FOV: 45 degrees; fundus photo; image size 2048x1536
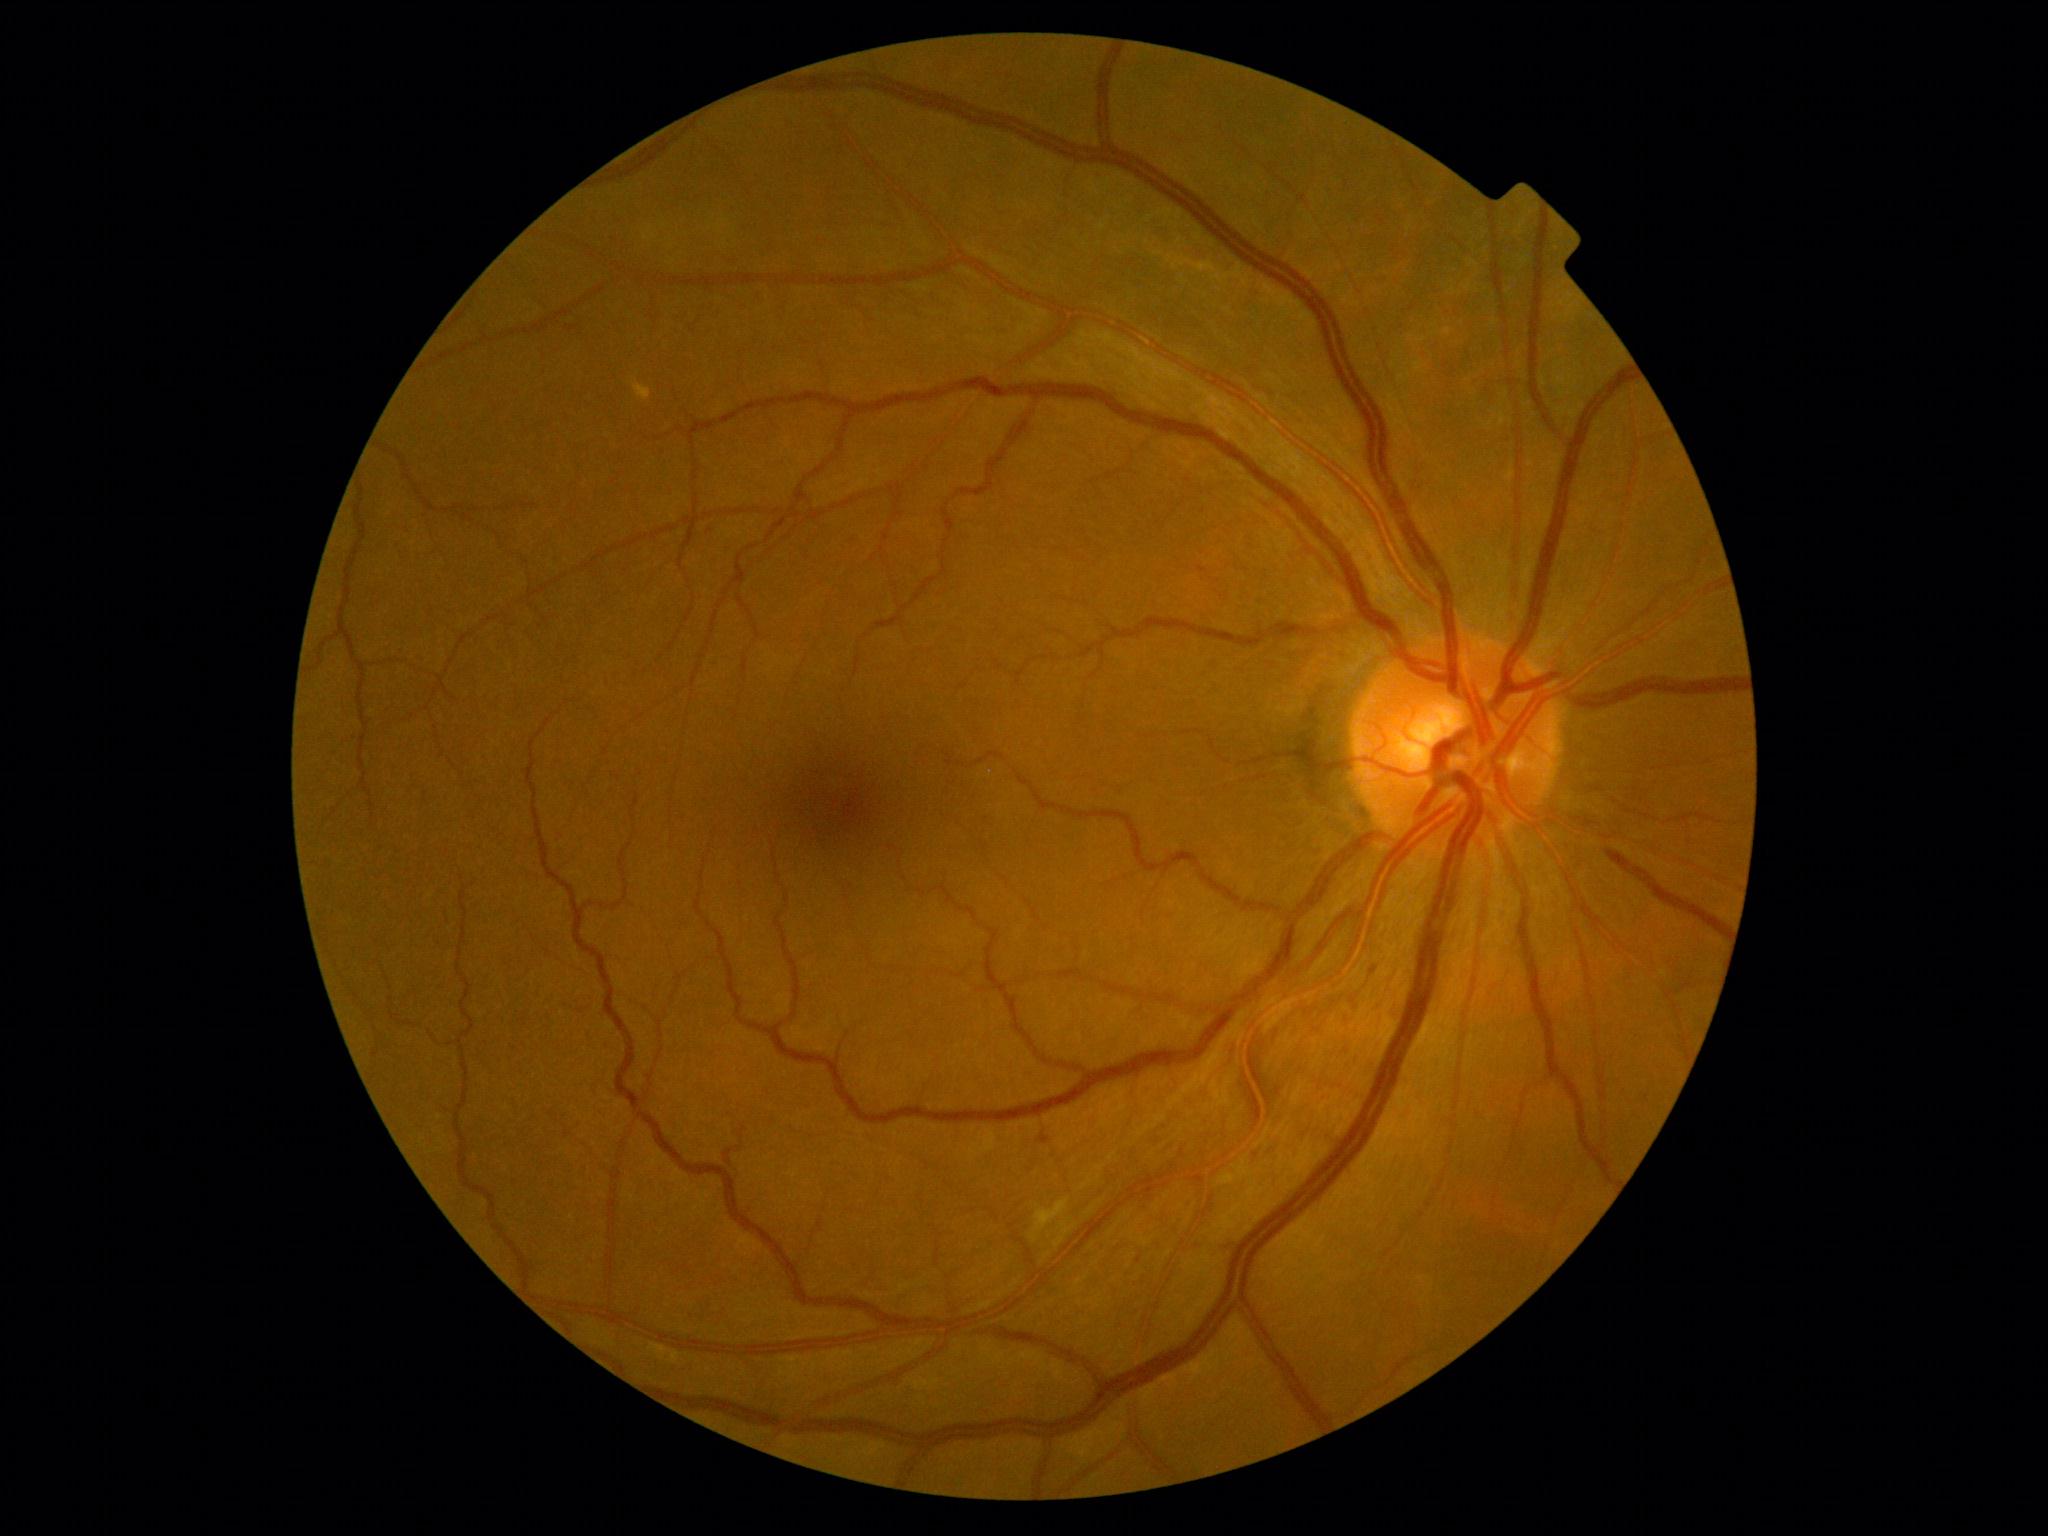
Disease class: non-proliferative diabetic retinopathy. DR is 1/4.